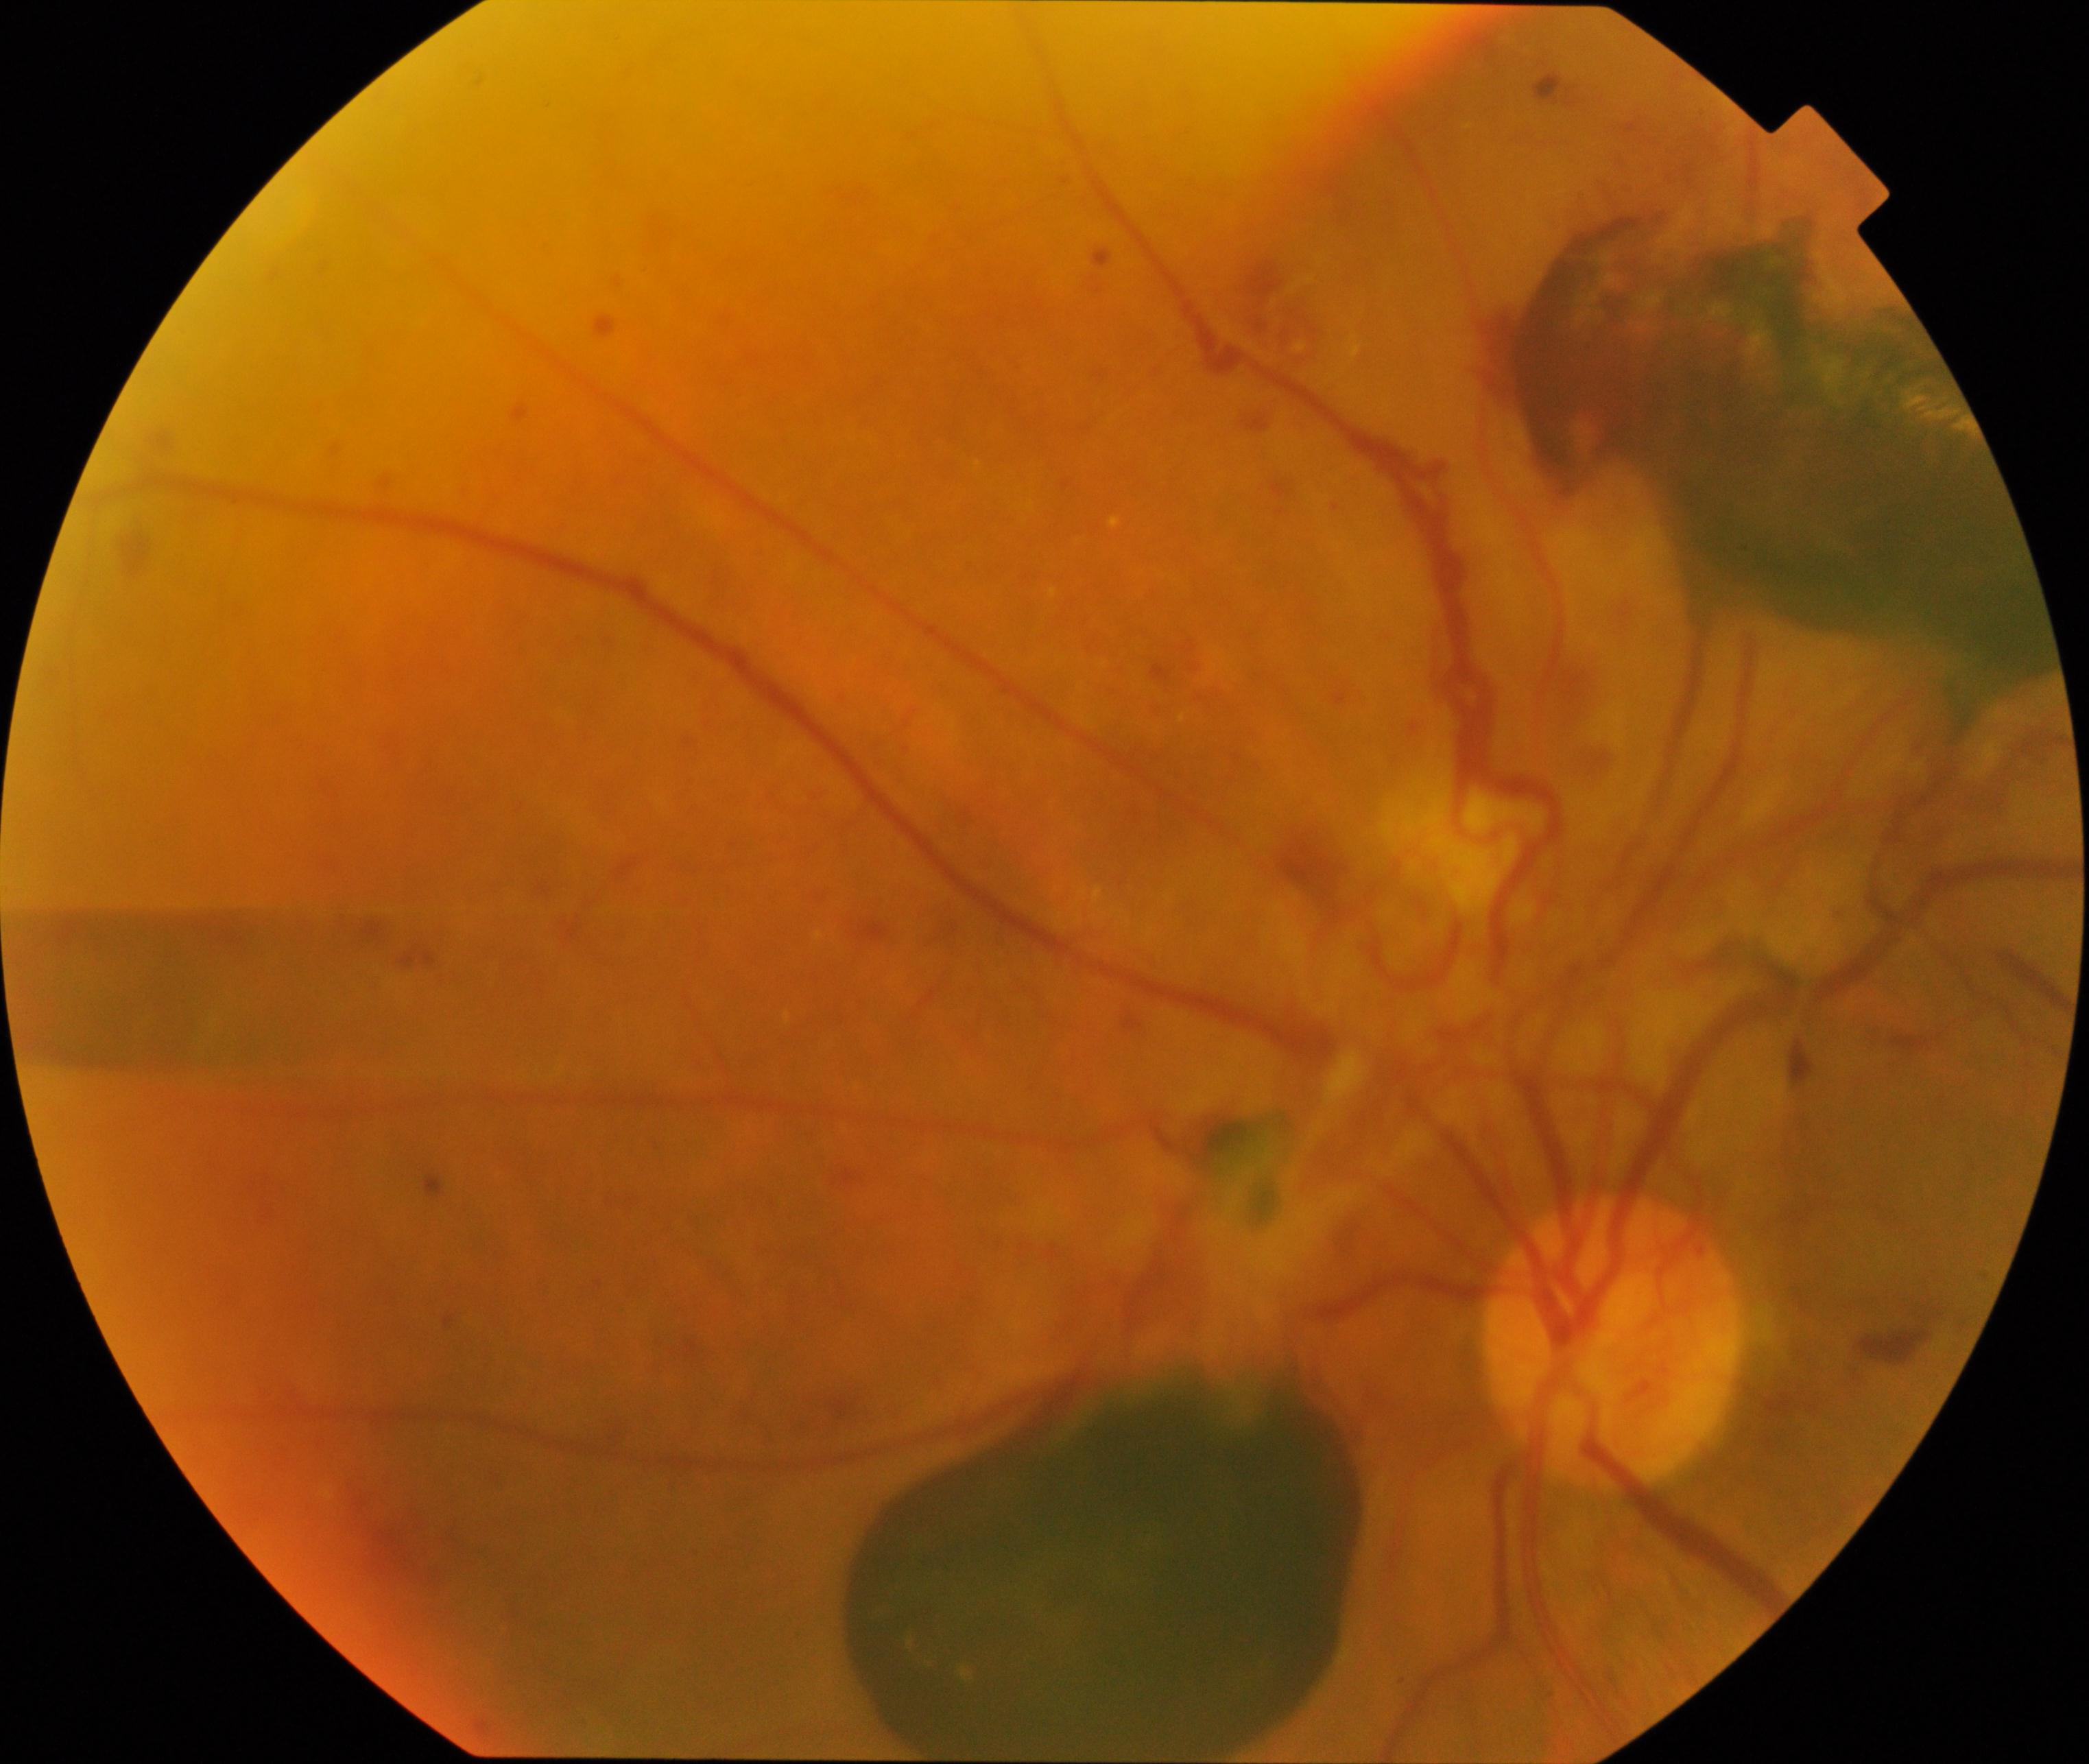

Findings consistent with severe non-proliferative or proliferative diabetic retinopathy. Typically showing severe non-proliferative diabetic retinopathy or proliferative diabetic retinopathy with neovascularization or vitreous/preretinal hemorrhage.